Camera: Natus RetCam Envision (130° FOV); pediatric wide-field fundus photograph.
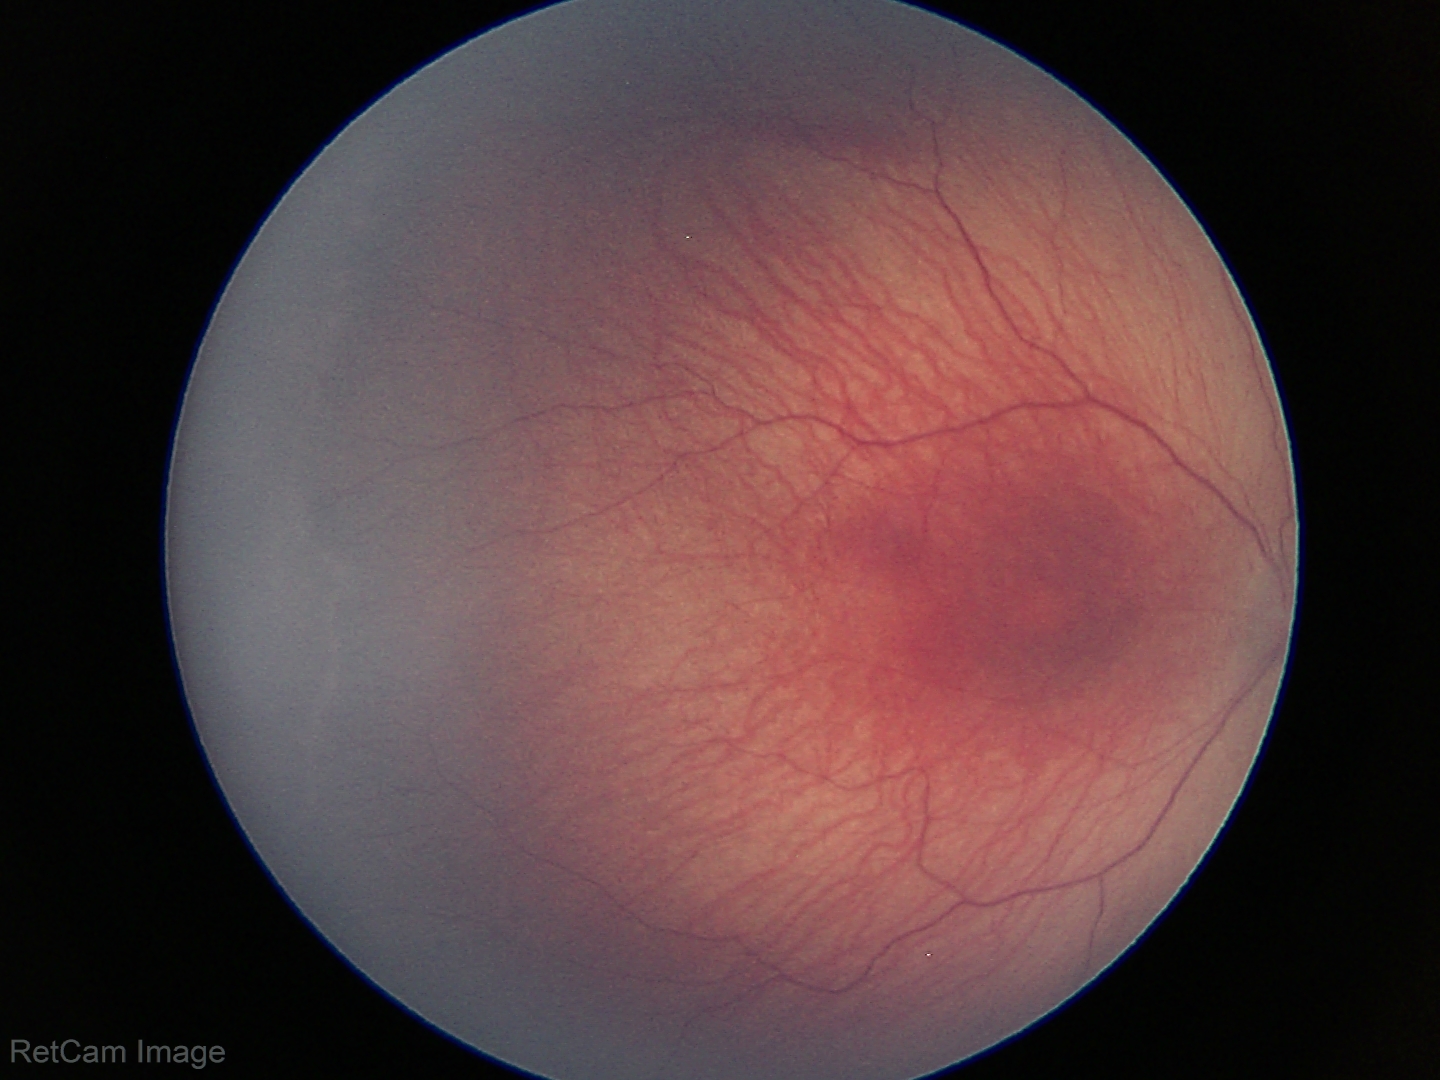 Plus disease absent. Screening series with ROP stage 1.